Posterior pole color fundus photograph; image size 848x848: 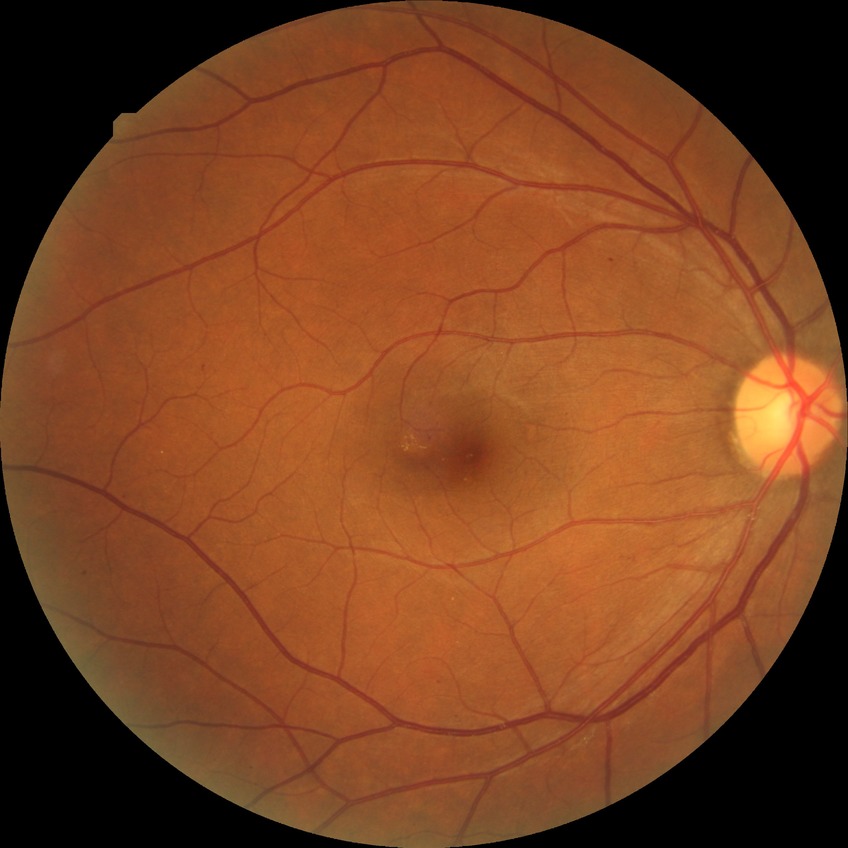
DR is SDR.
The retinopathy is classified as non-proliferative diabetic retinopathy.